Camera: NIDEK AFC-230, 45° field of view, posterior pole photograph, no pharmacologic dilation: 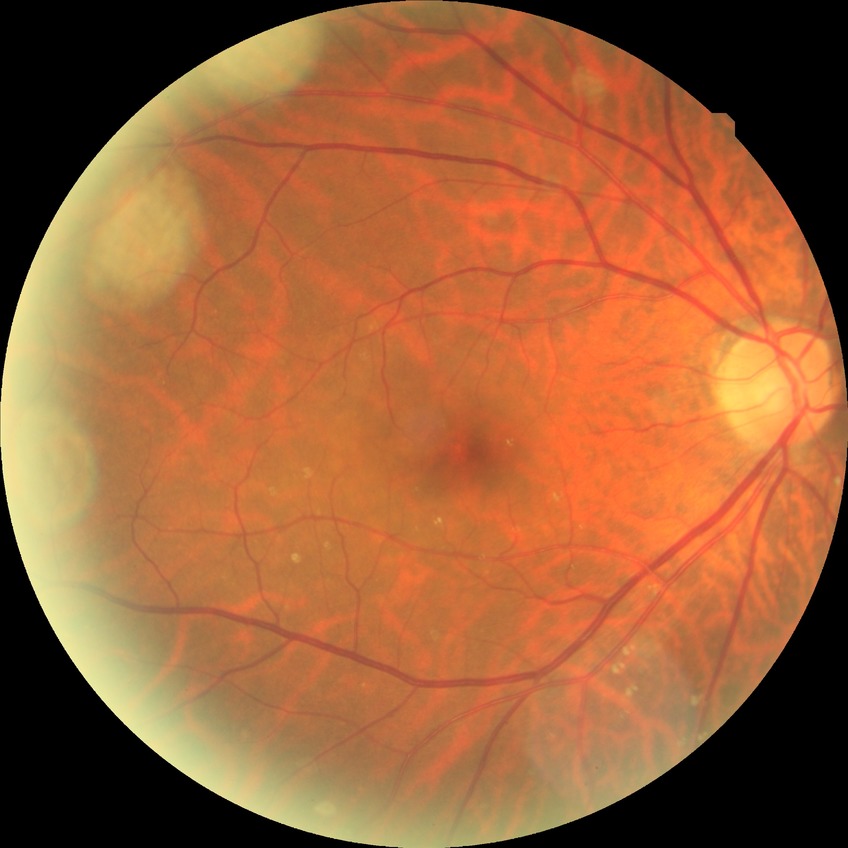
davis_grade: NDR (no diabetic retinopathy)